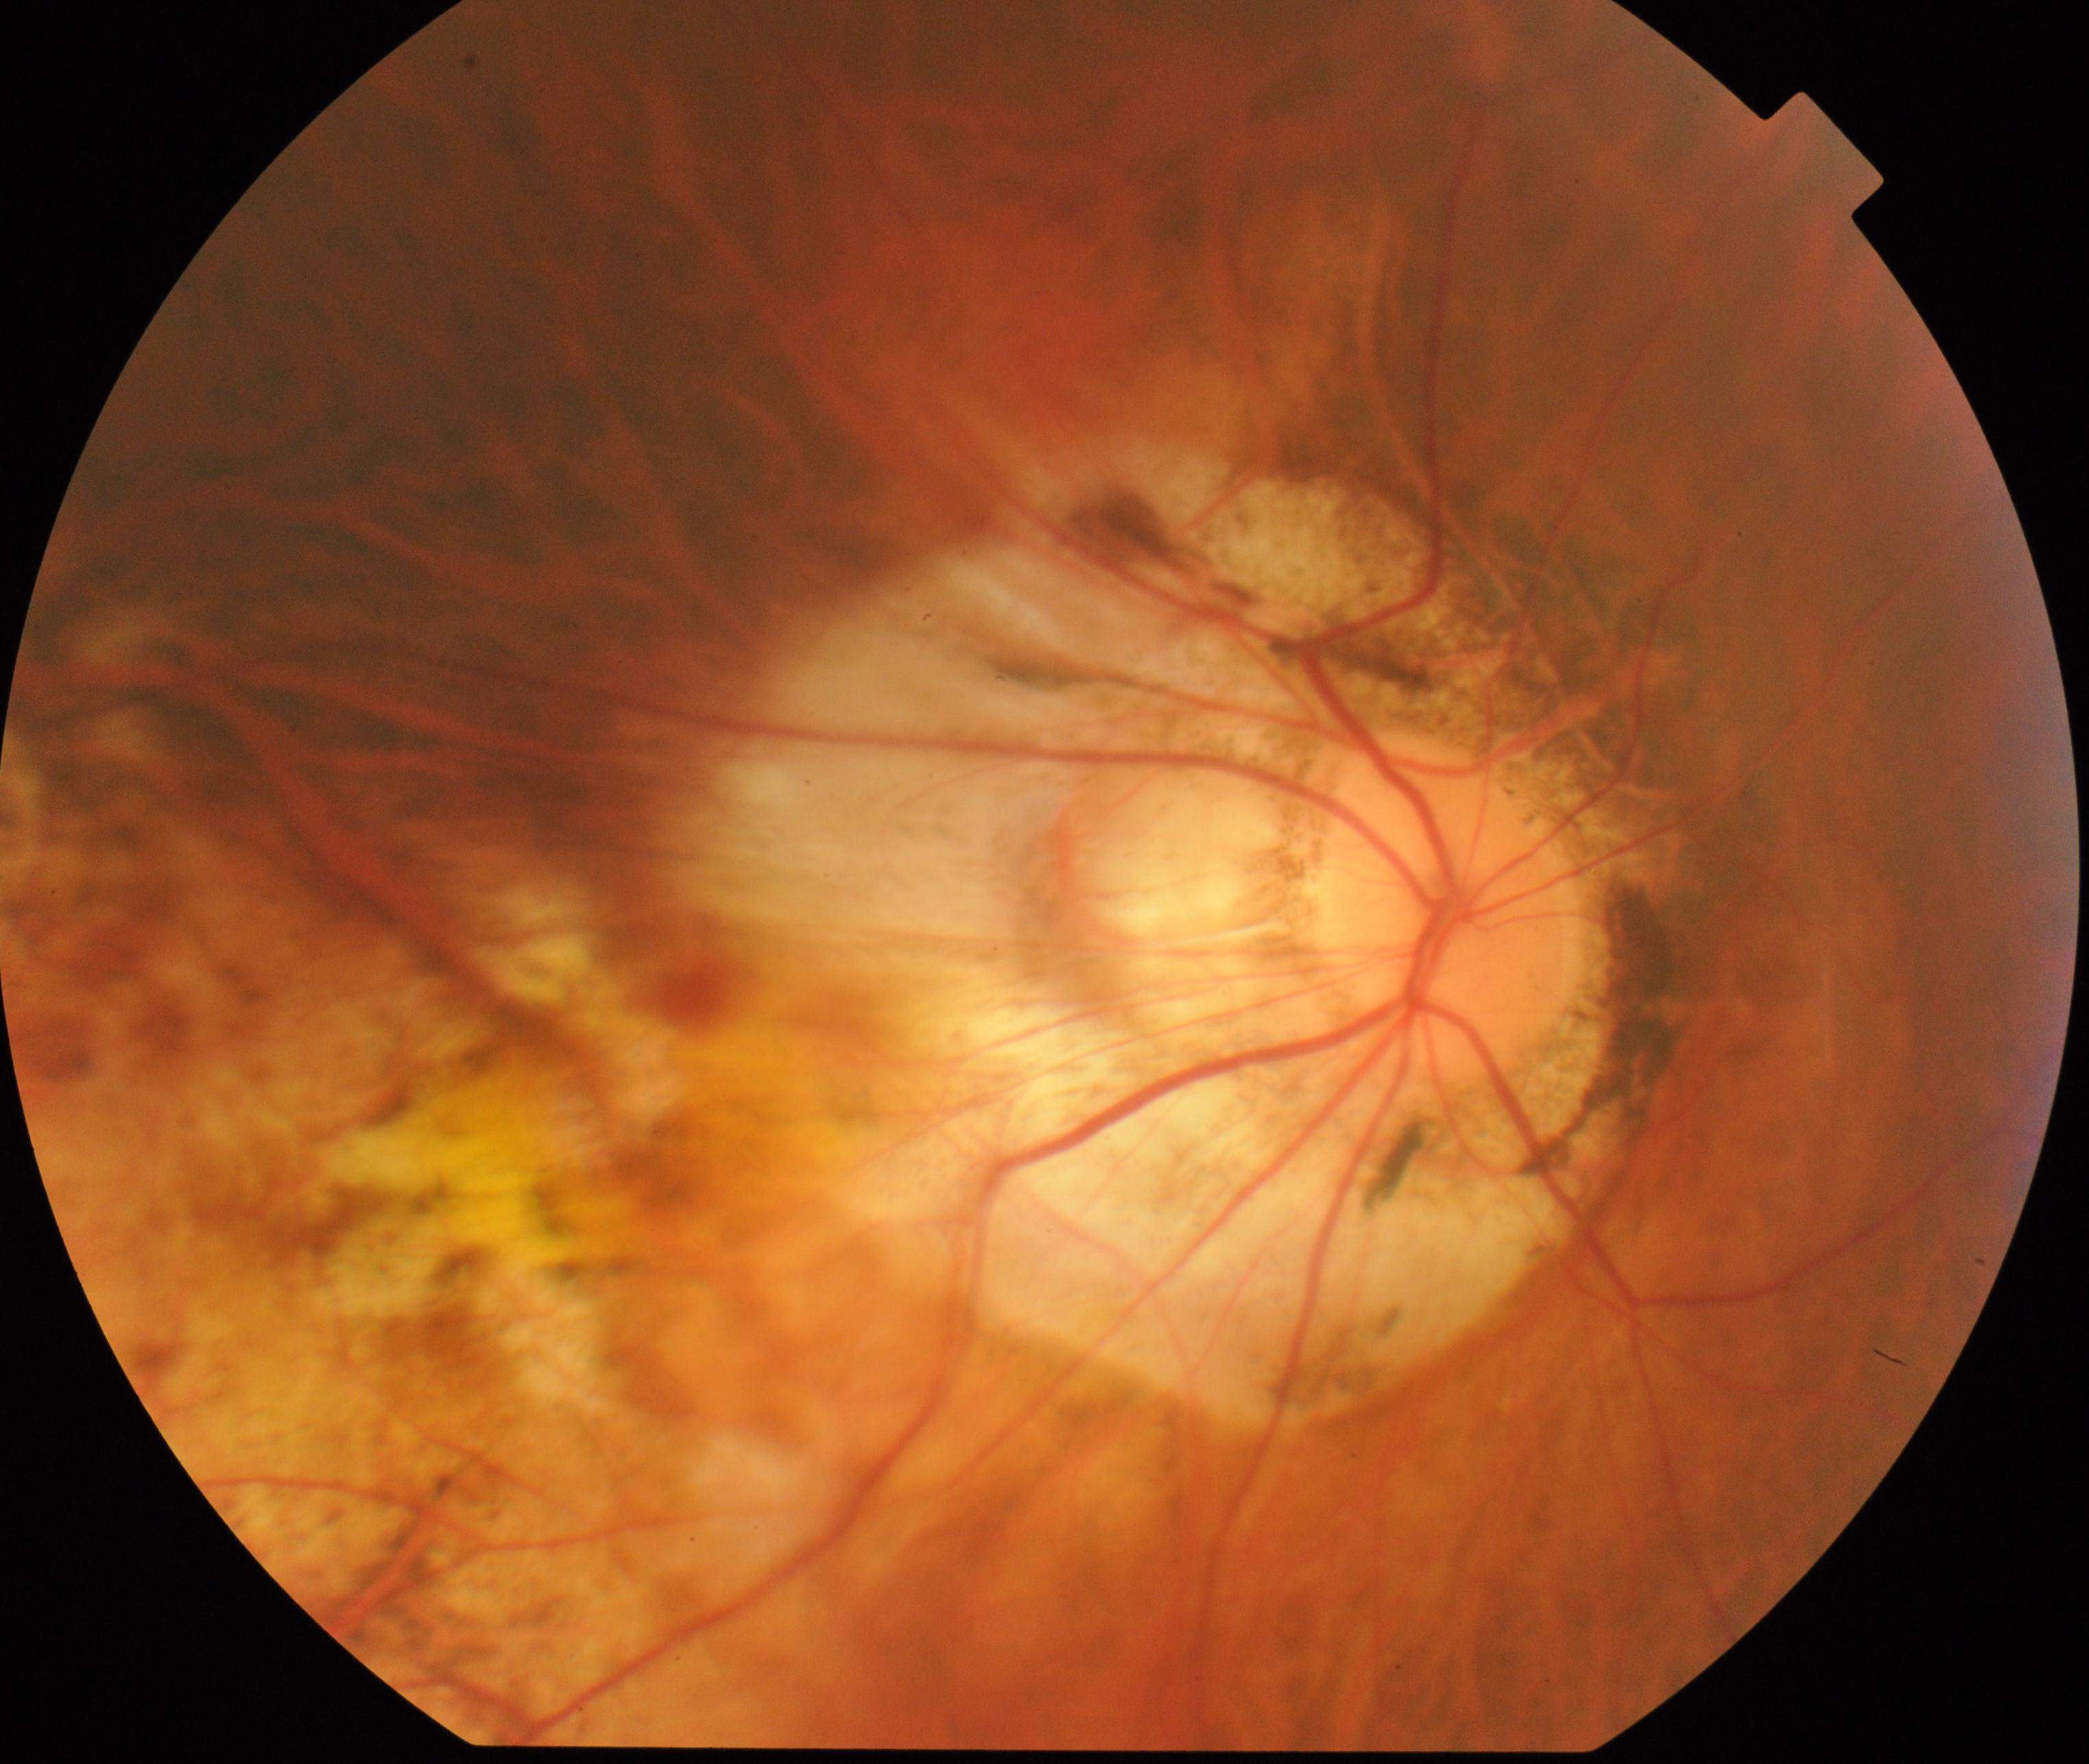 Primary finding: pathological myopia. Characterized by tessellated fundus with focal chorioretinal atrophy, Fuchs spot, lacquer cracks, choroidal neovascularization, or subretinal hemorrhage.